Captured after pupil dilation: 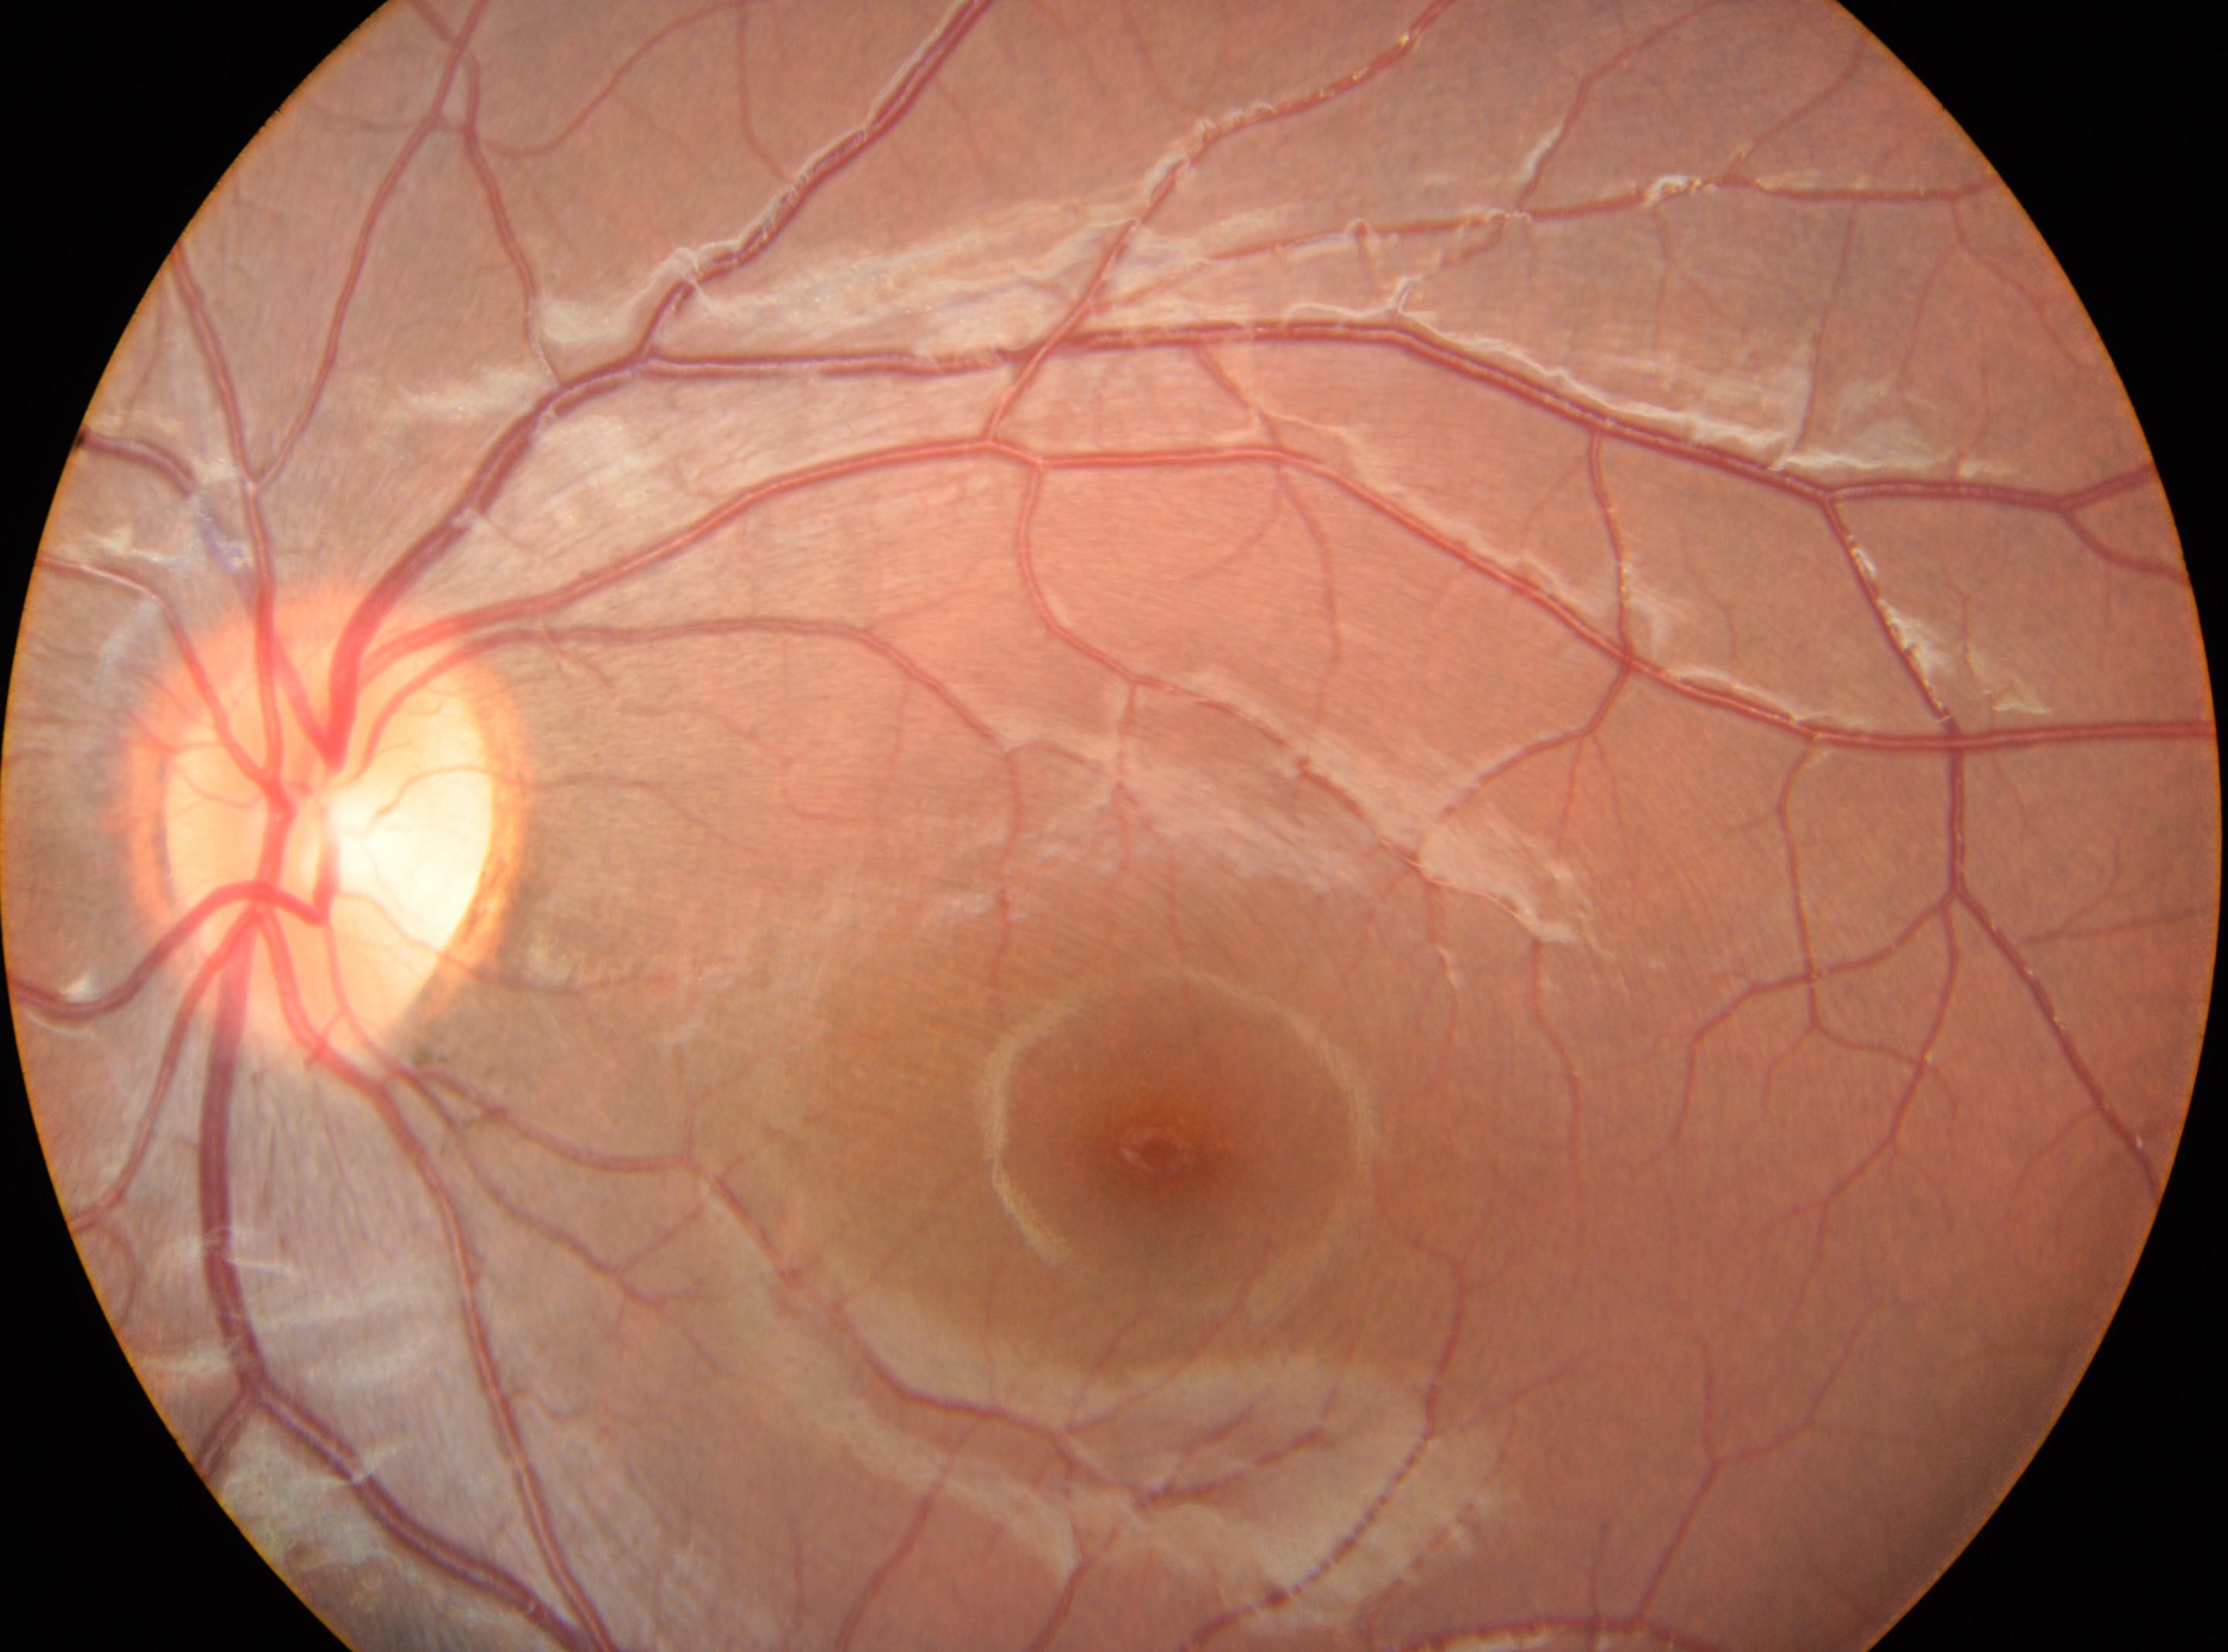 This is the left eye. Optic disc center: (333, 844). DR stage: grade 0. The fovea center is at (1154, 1151).